Posterior pole photograph · DR severity per modified Davis staging.
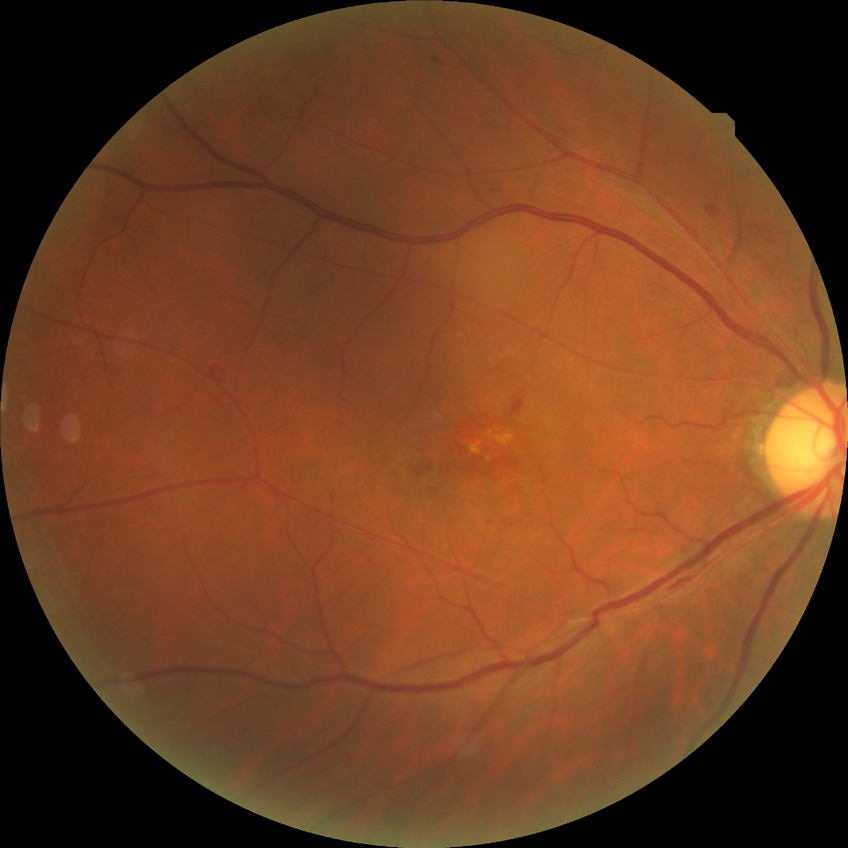 diabetic retinopathy (DR) = SDR (simple diabetic retinopathy).